Camera: NIDEK AFC-230 · nonmydriatic fundus photograph · diabetic retinopathy graded by the modified Davis classification:
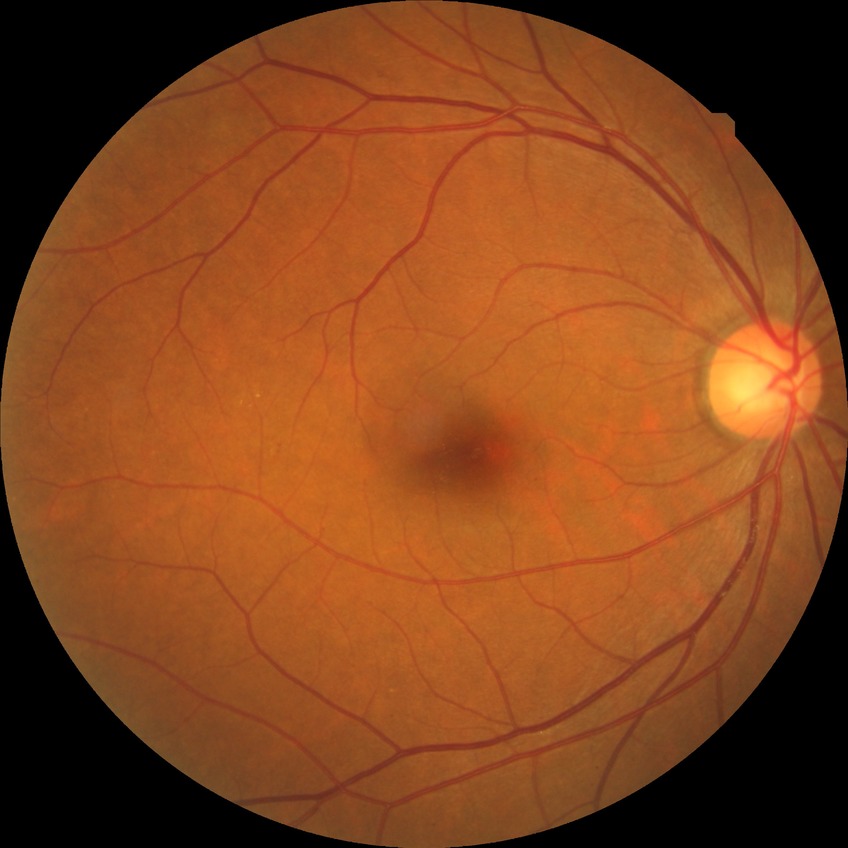

Findings:
* diabetic retinopathy (DR): simple diabetic retinopathy (SDR)